45-degree field of view. DR severity per modified Davis staging
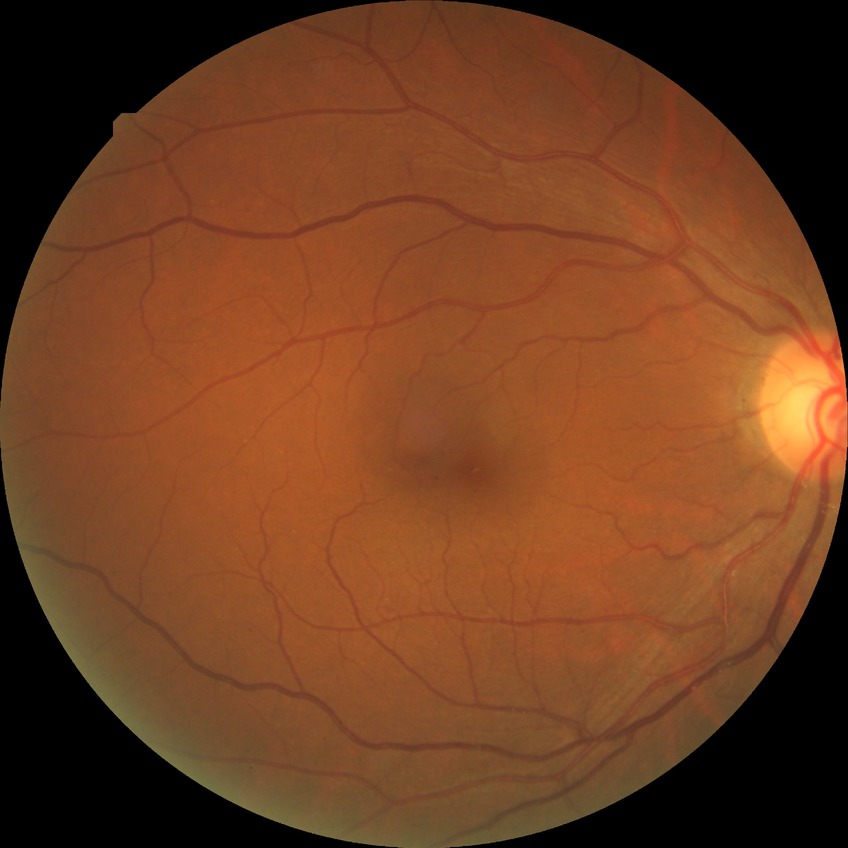

DR grade is NDR.
No signs of diabetic retinopathy.